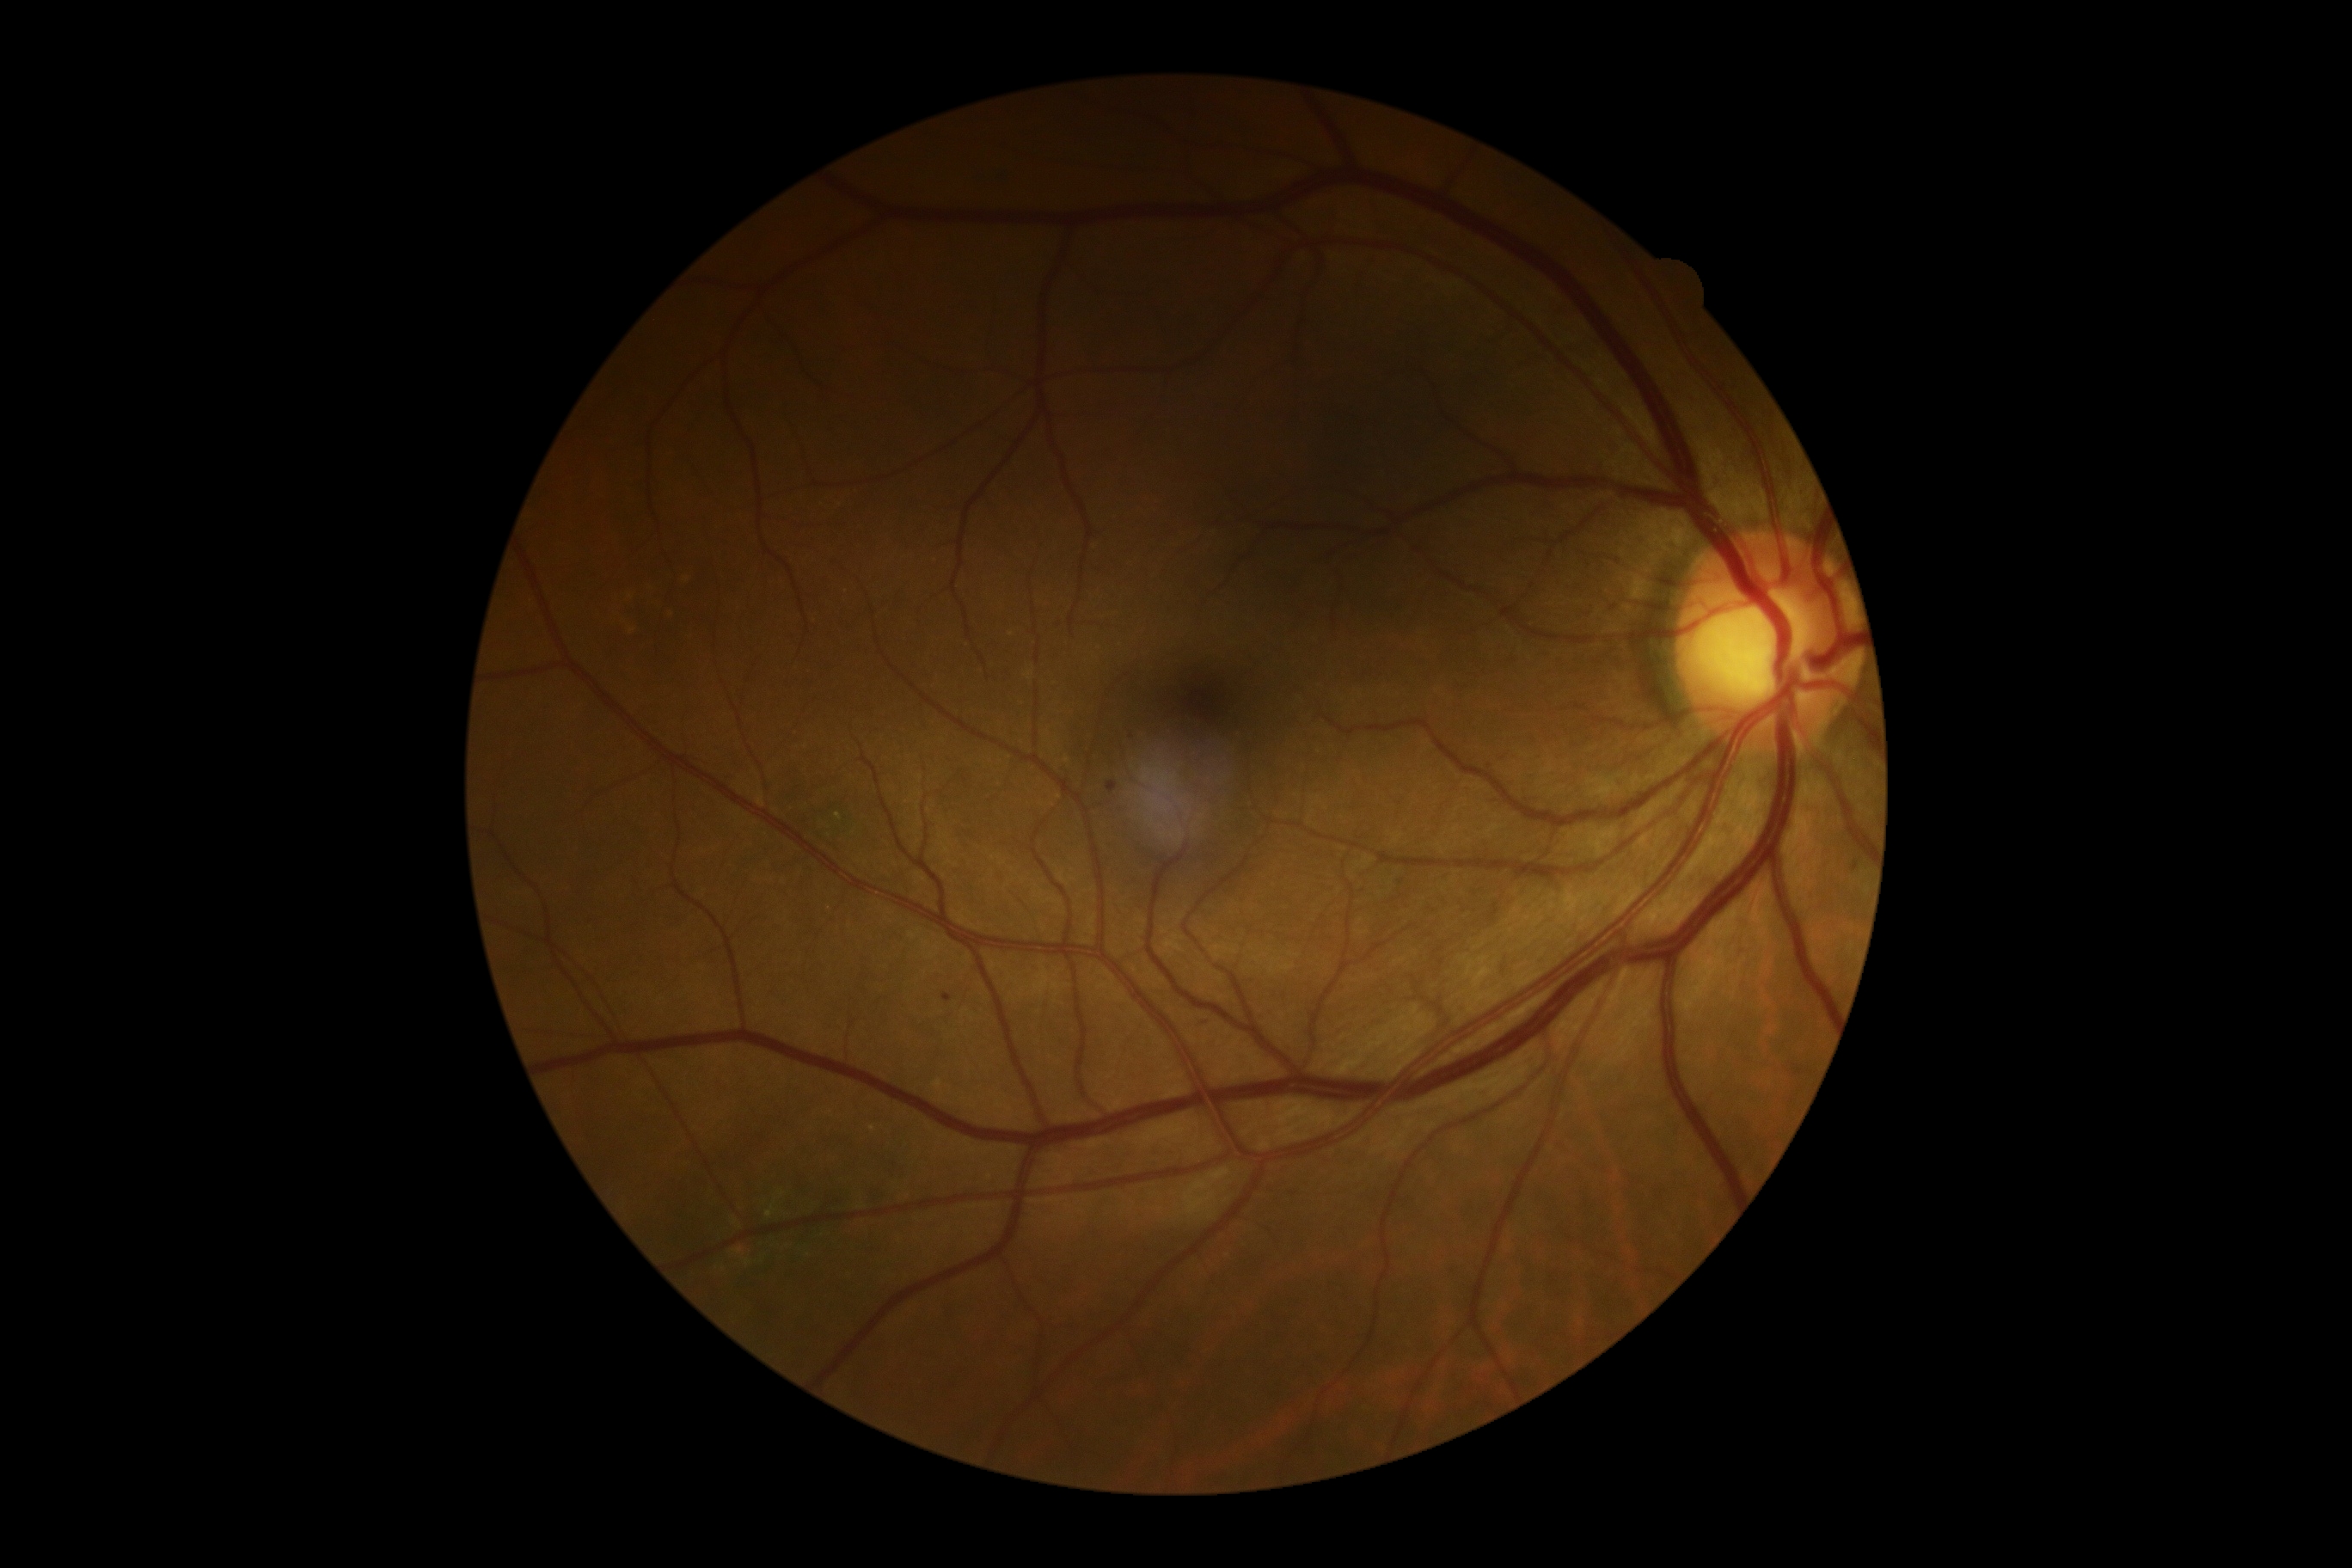 Retinopathy grade is 1 (mild NPDR).